Optic disc-centered crop · non-mydriatic acquisition:
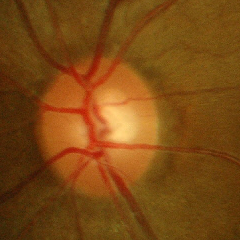 Glaucoma stage = no glaucomatous optic neuropathy.